1659 x 2212 pixels. Retinal fundus photograph. Acquired with a Remidio Fundus on Phone
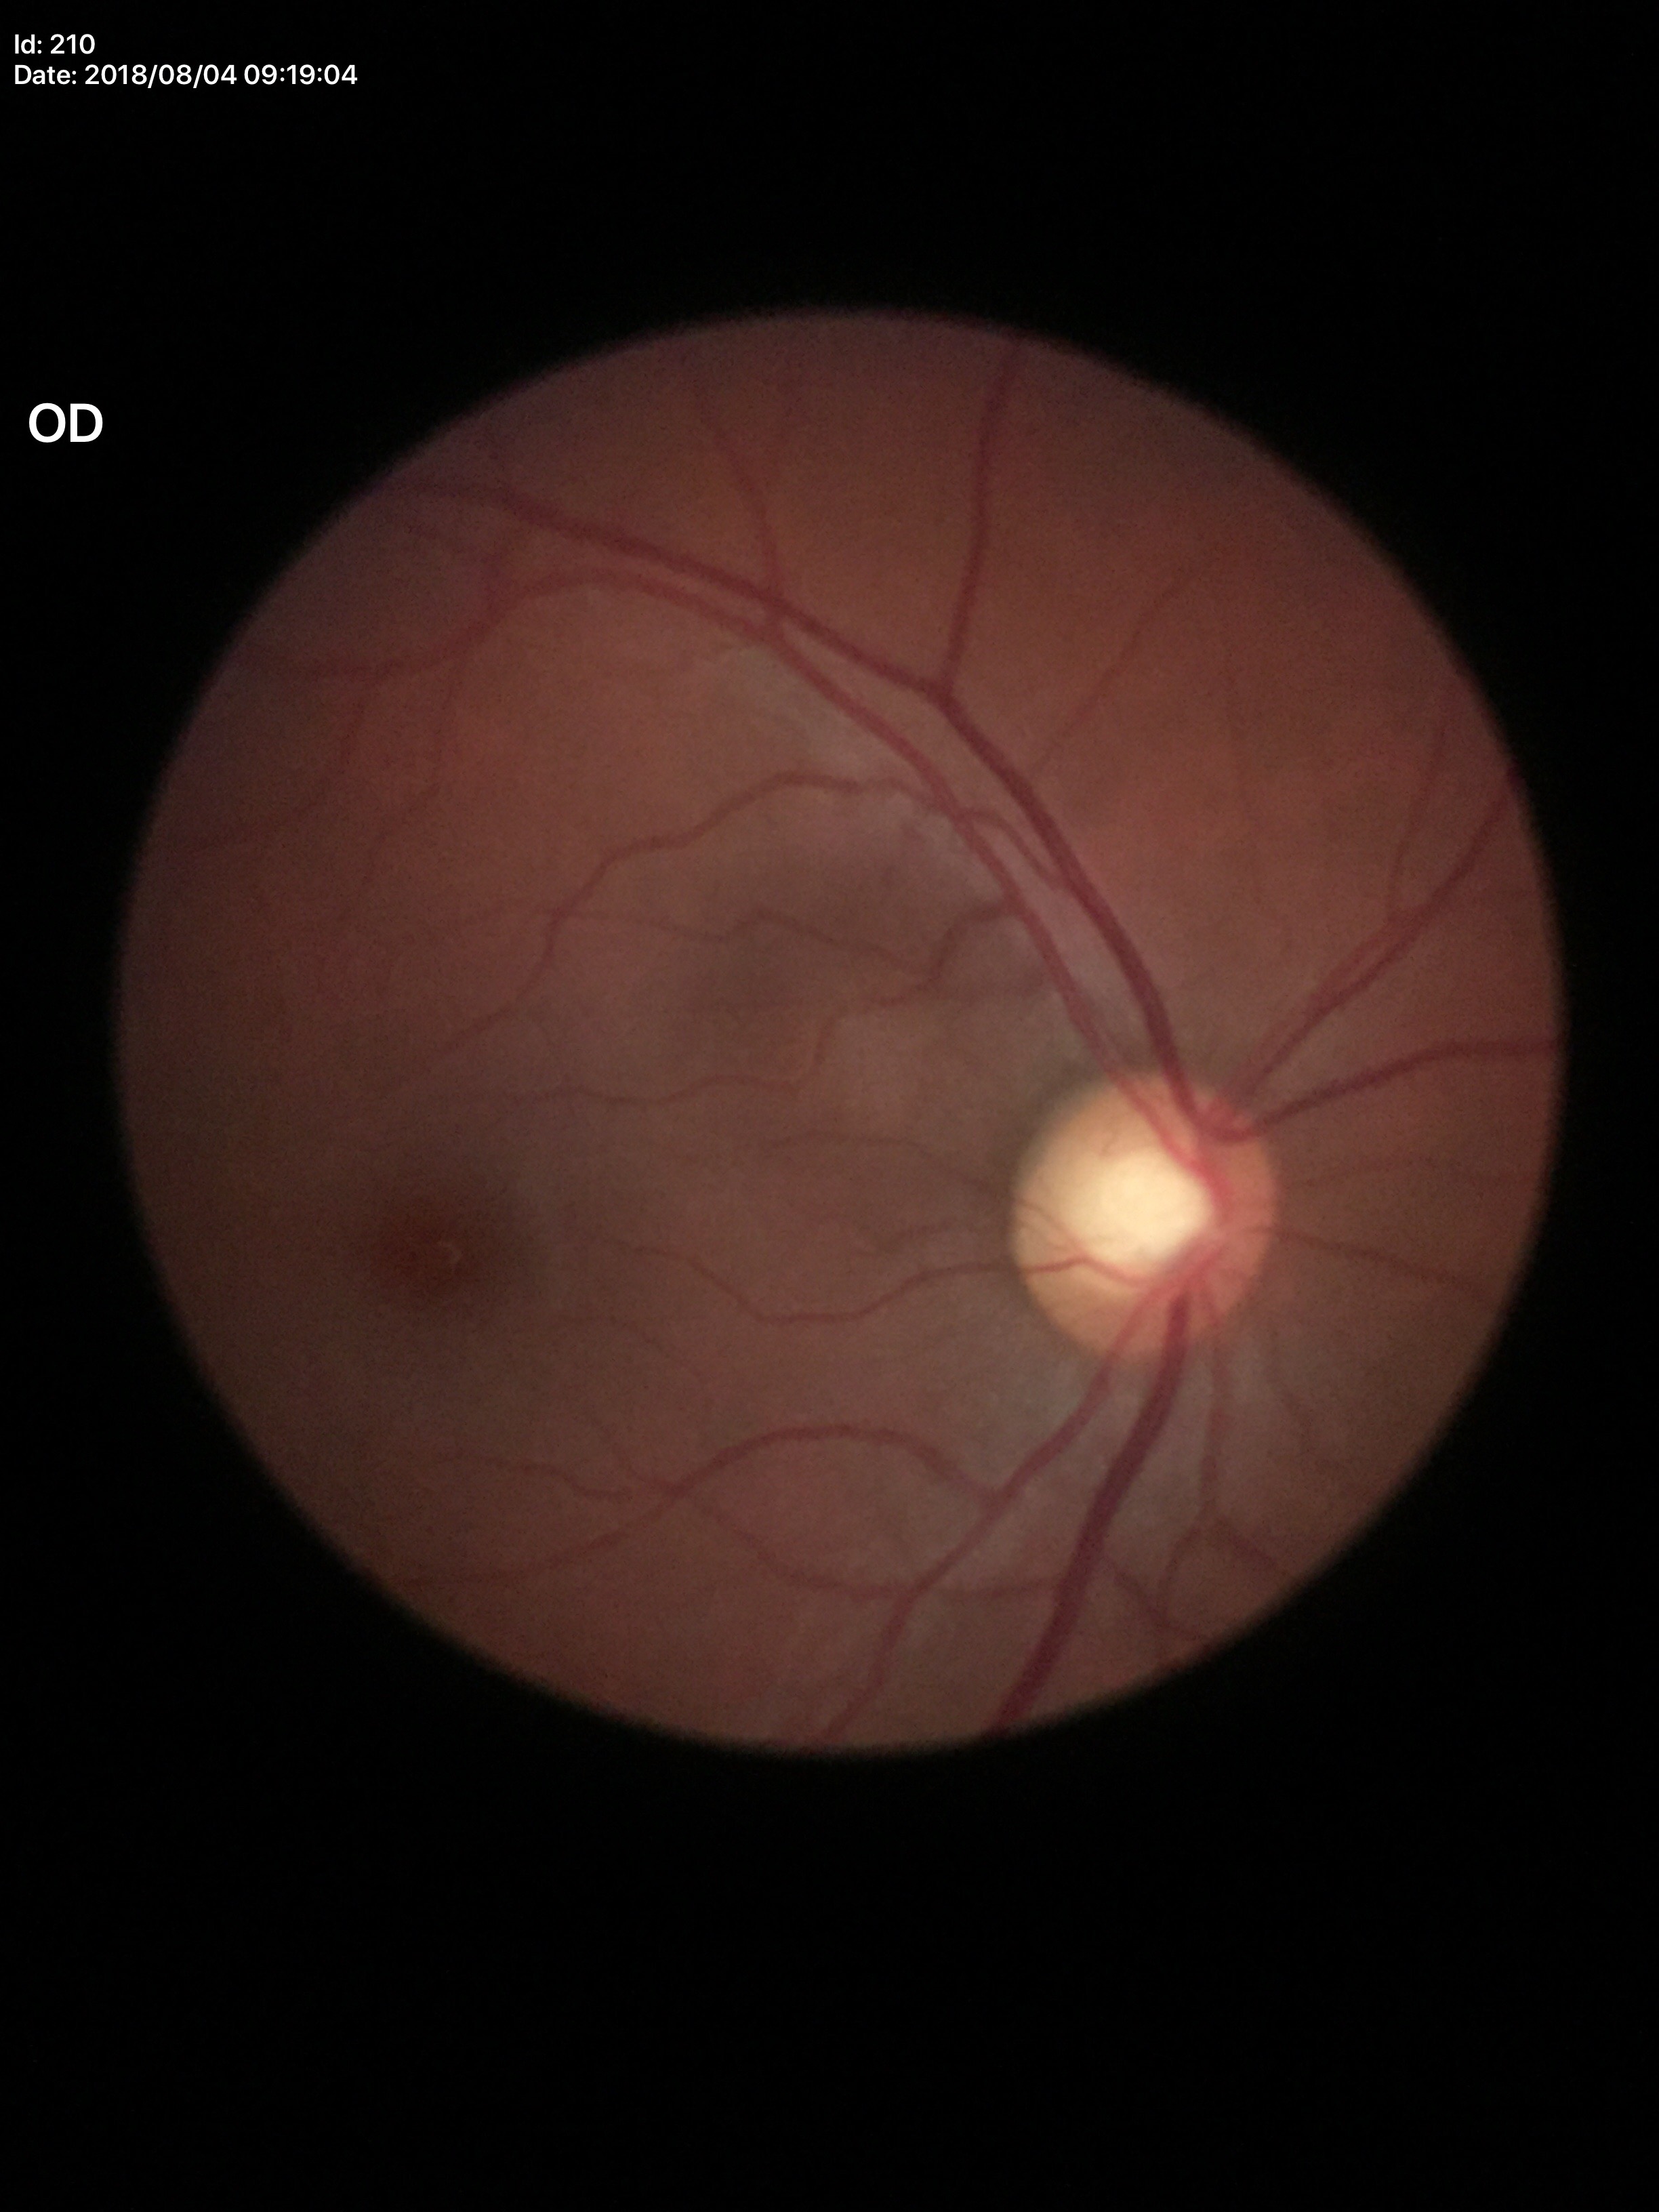

{"vcdr": "0.58", "hcdr": "0.64", "glaucoma_decision": "no suspicious findings"}